45° field of view; CFP.
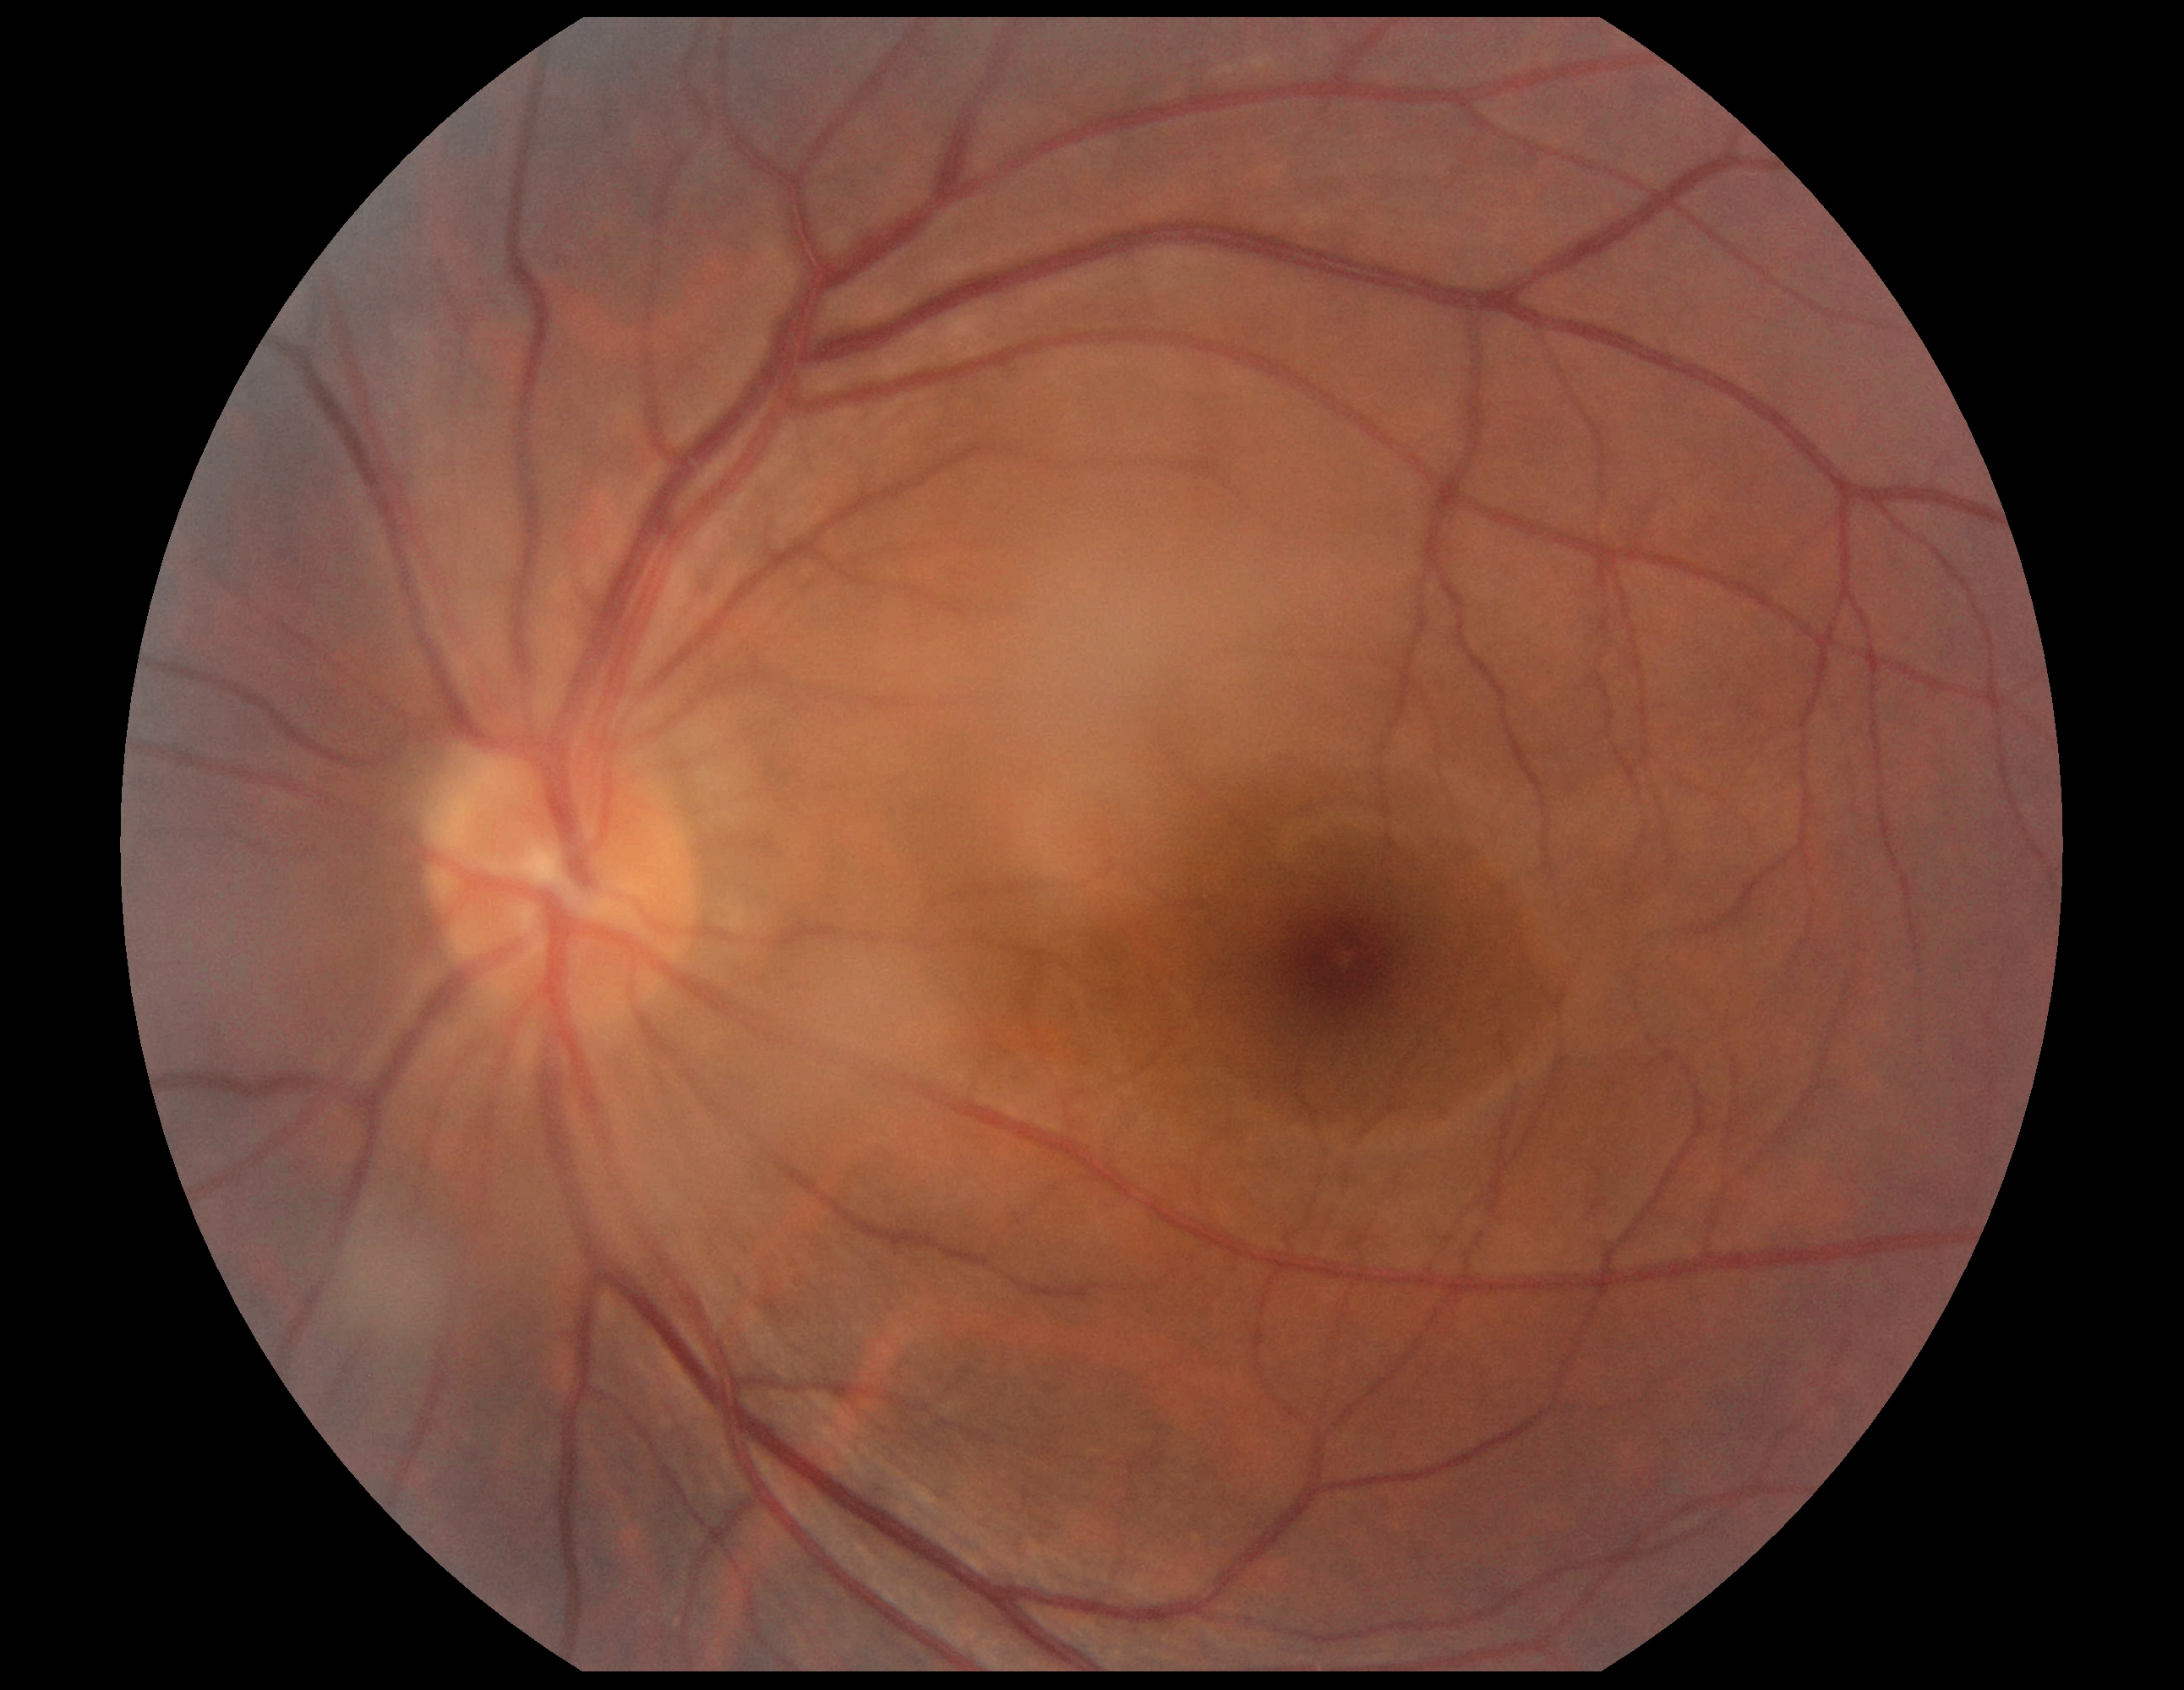

DR is no apparent diabetic retinopathy (grade 0) — no visible signs of diabetic retinopathy.